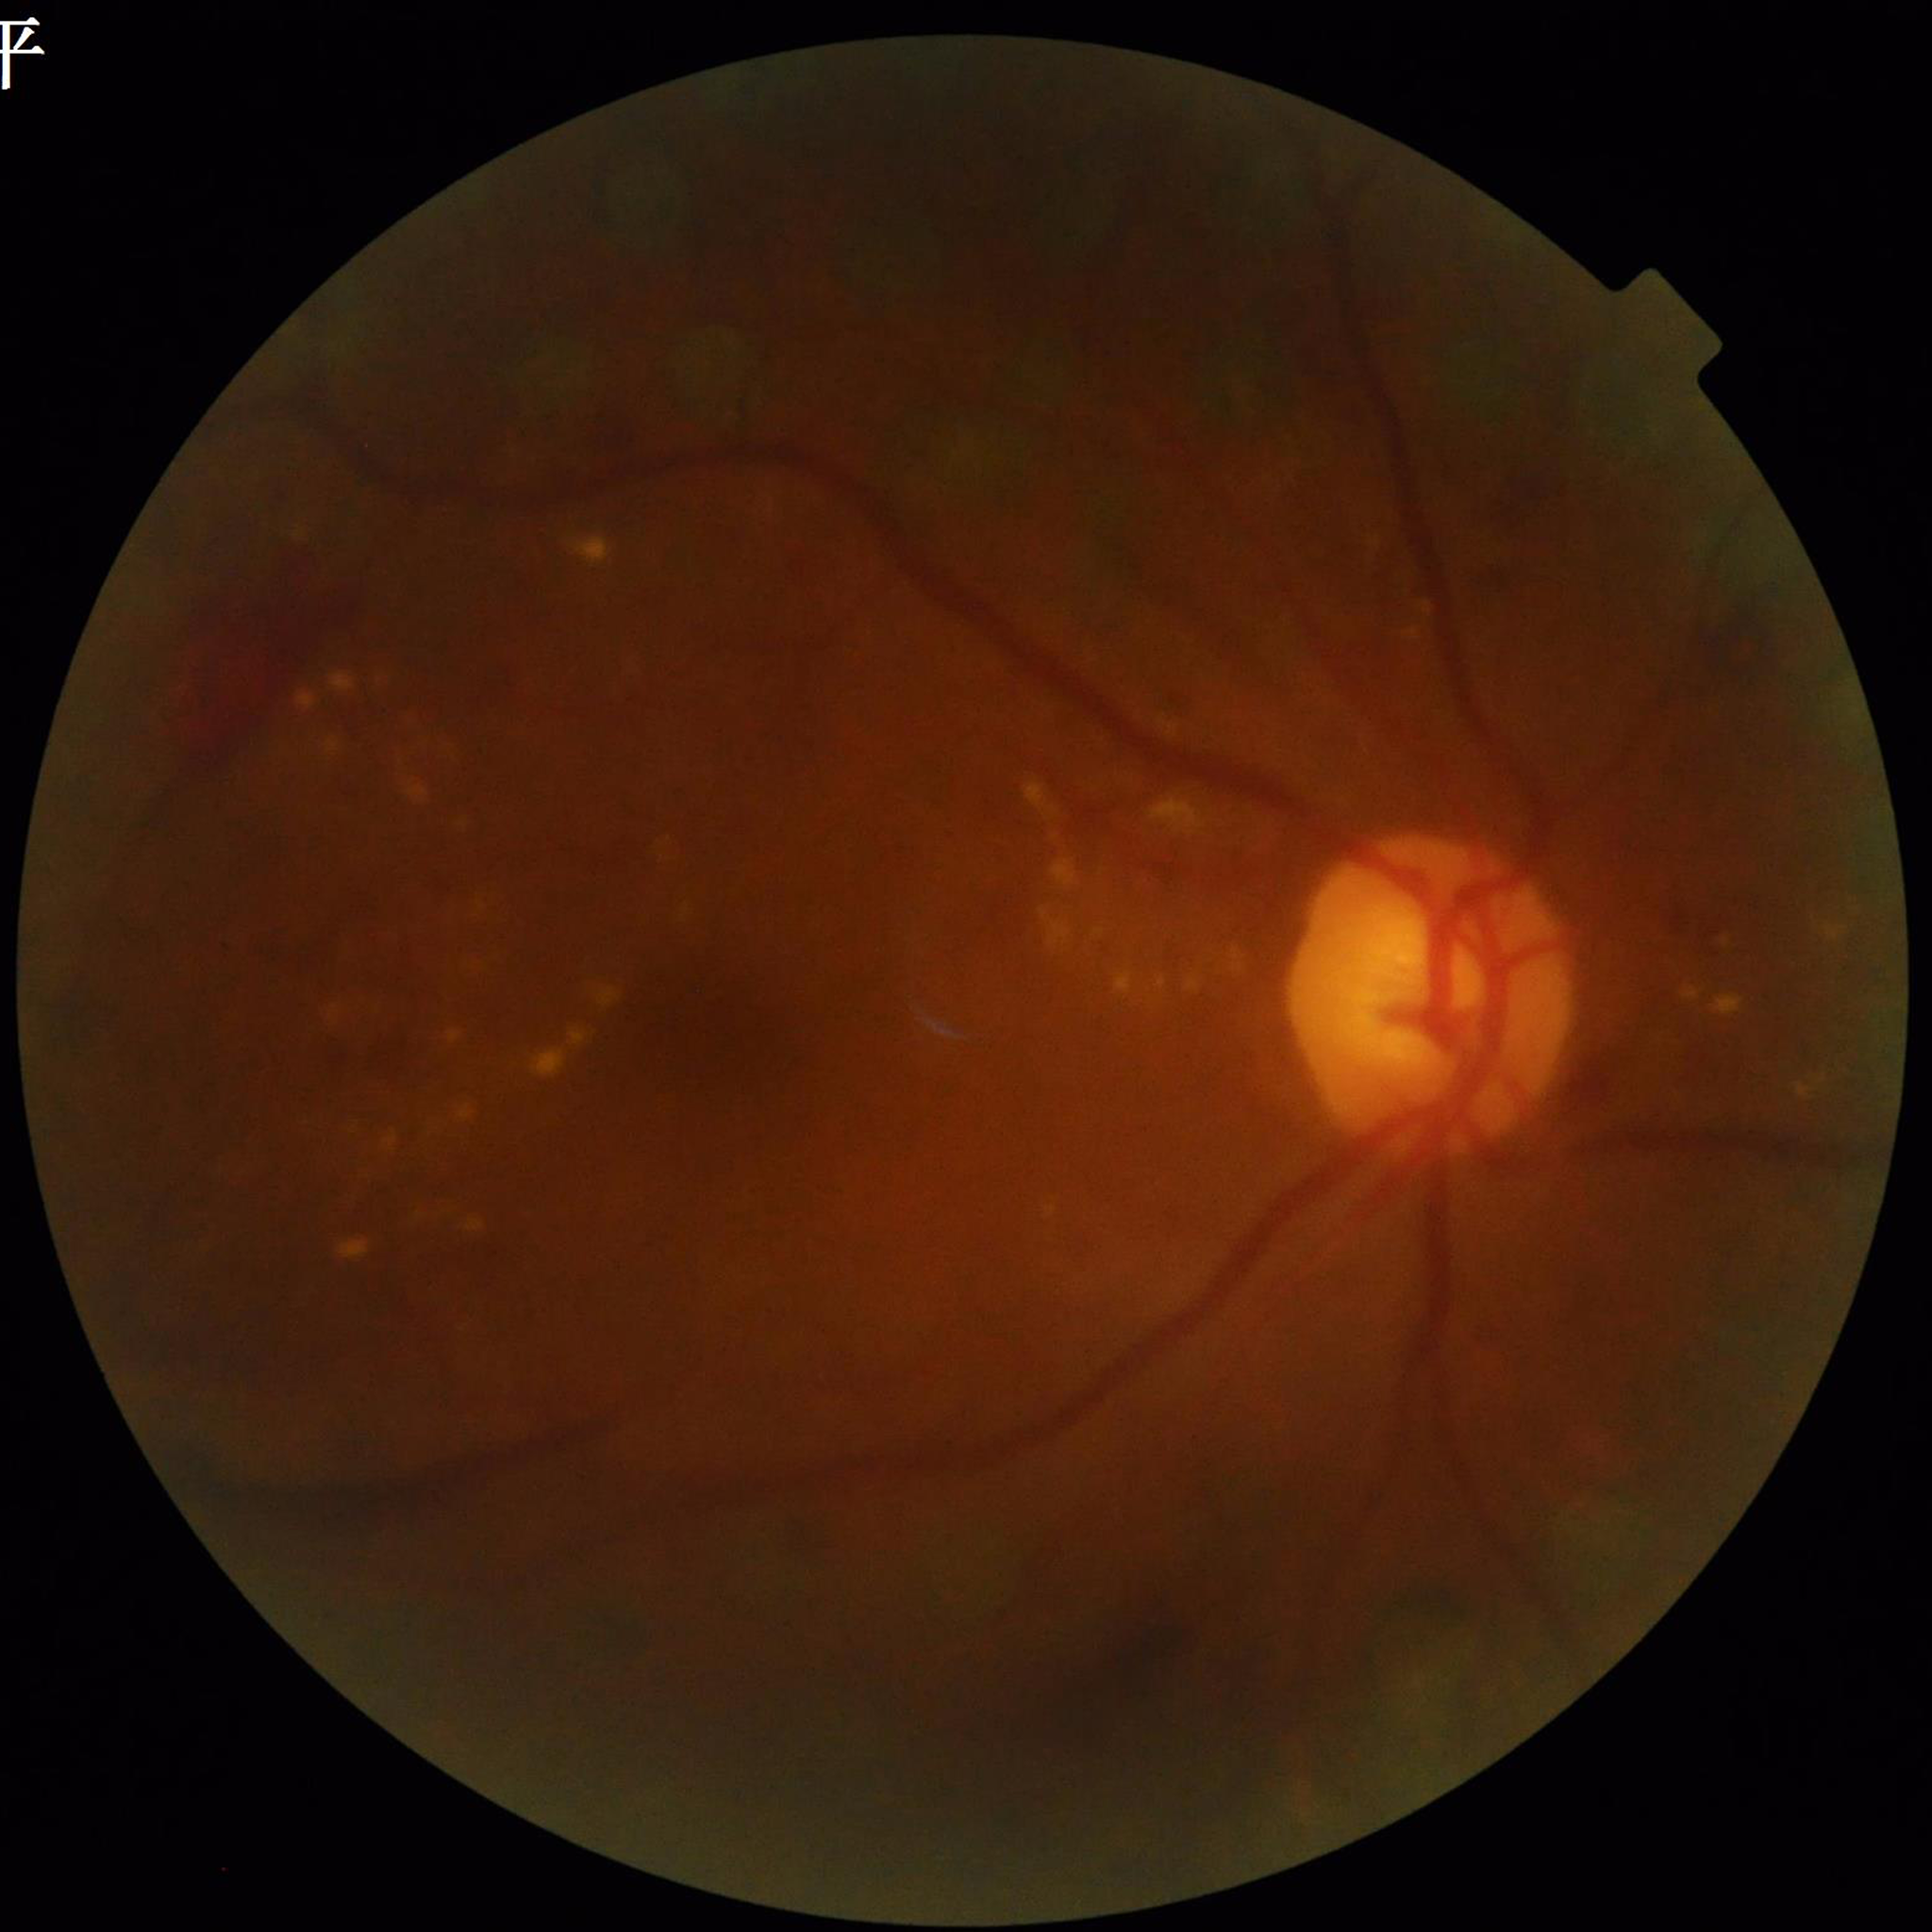 Automated quality assessment: suboptimal — illumination/color distortion, blur
Disease class: diabetic retinopathy (DR)